2346 x 1568 pixels. Retinal fundus photograph: 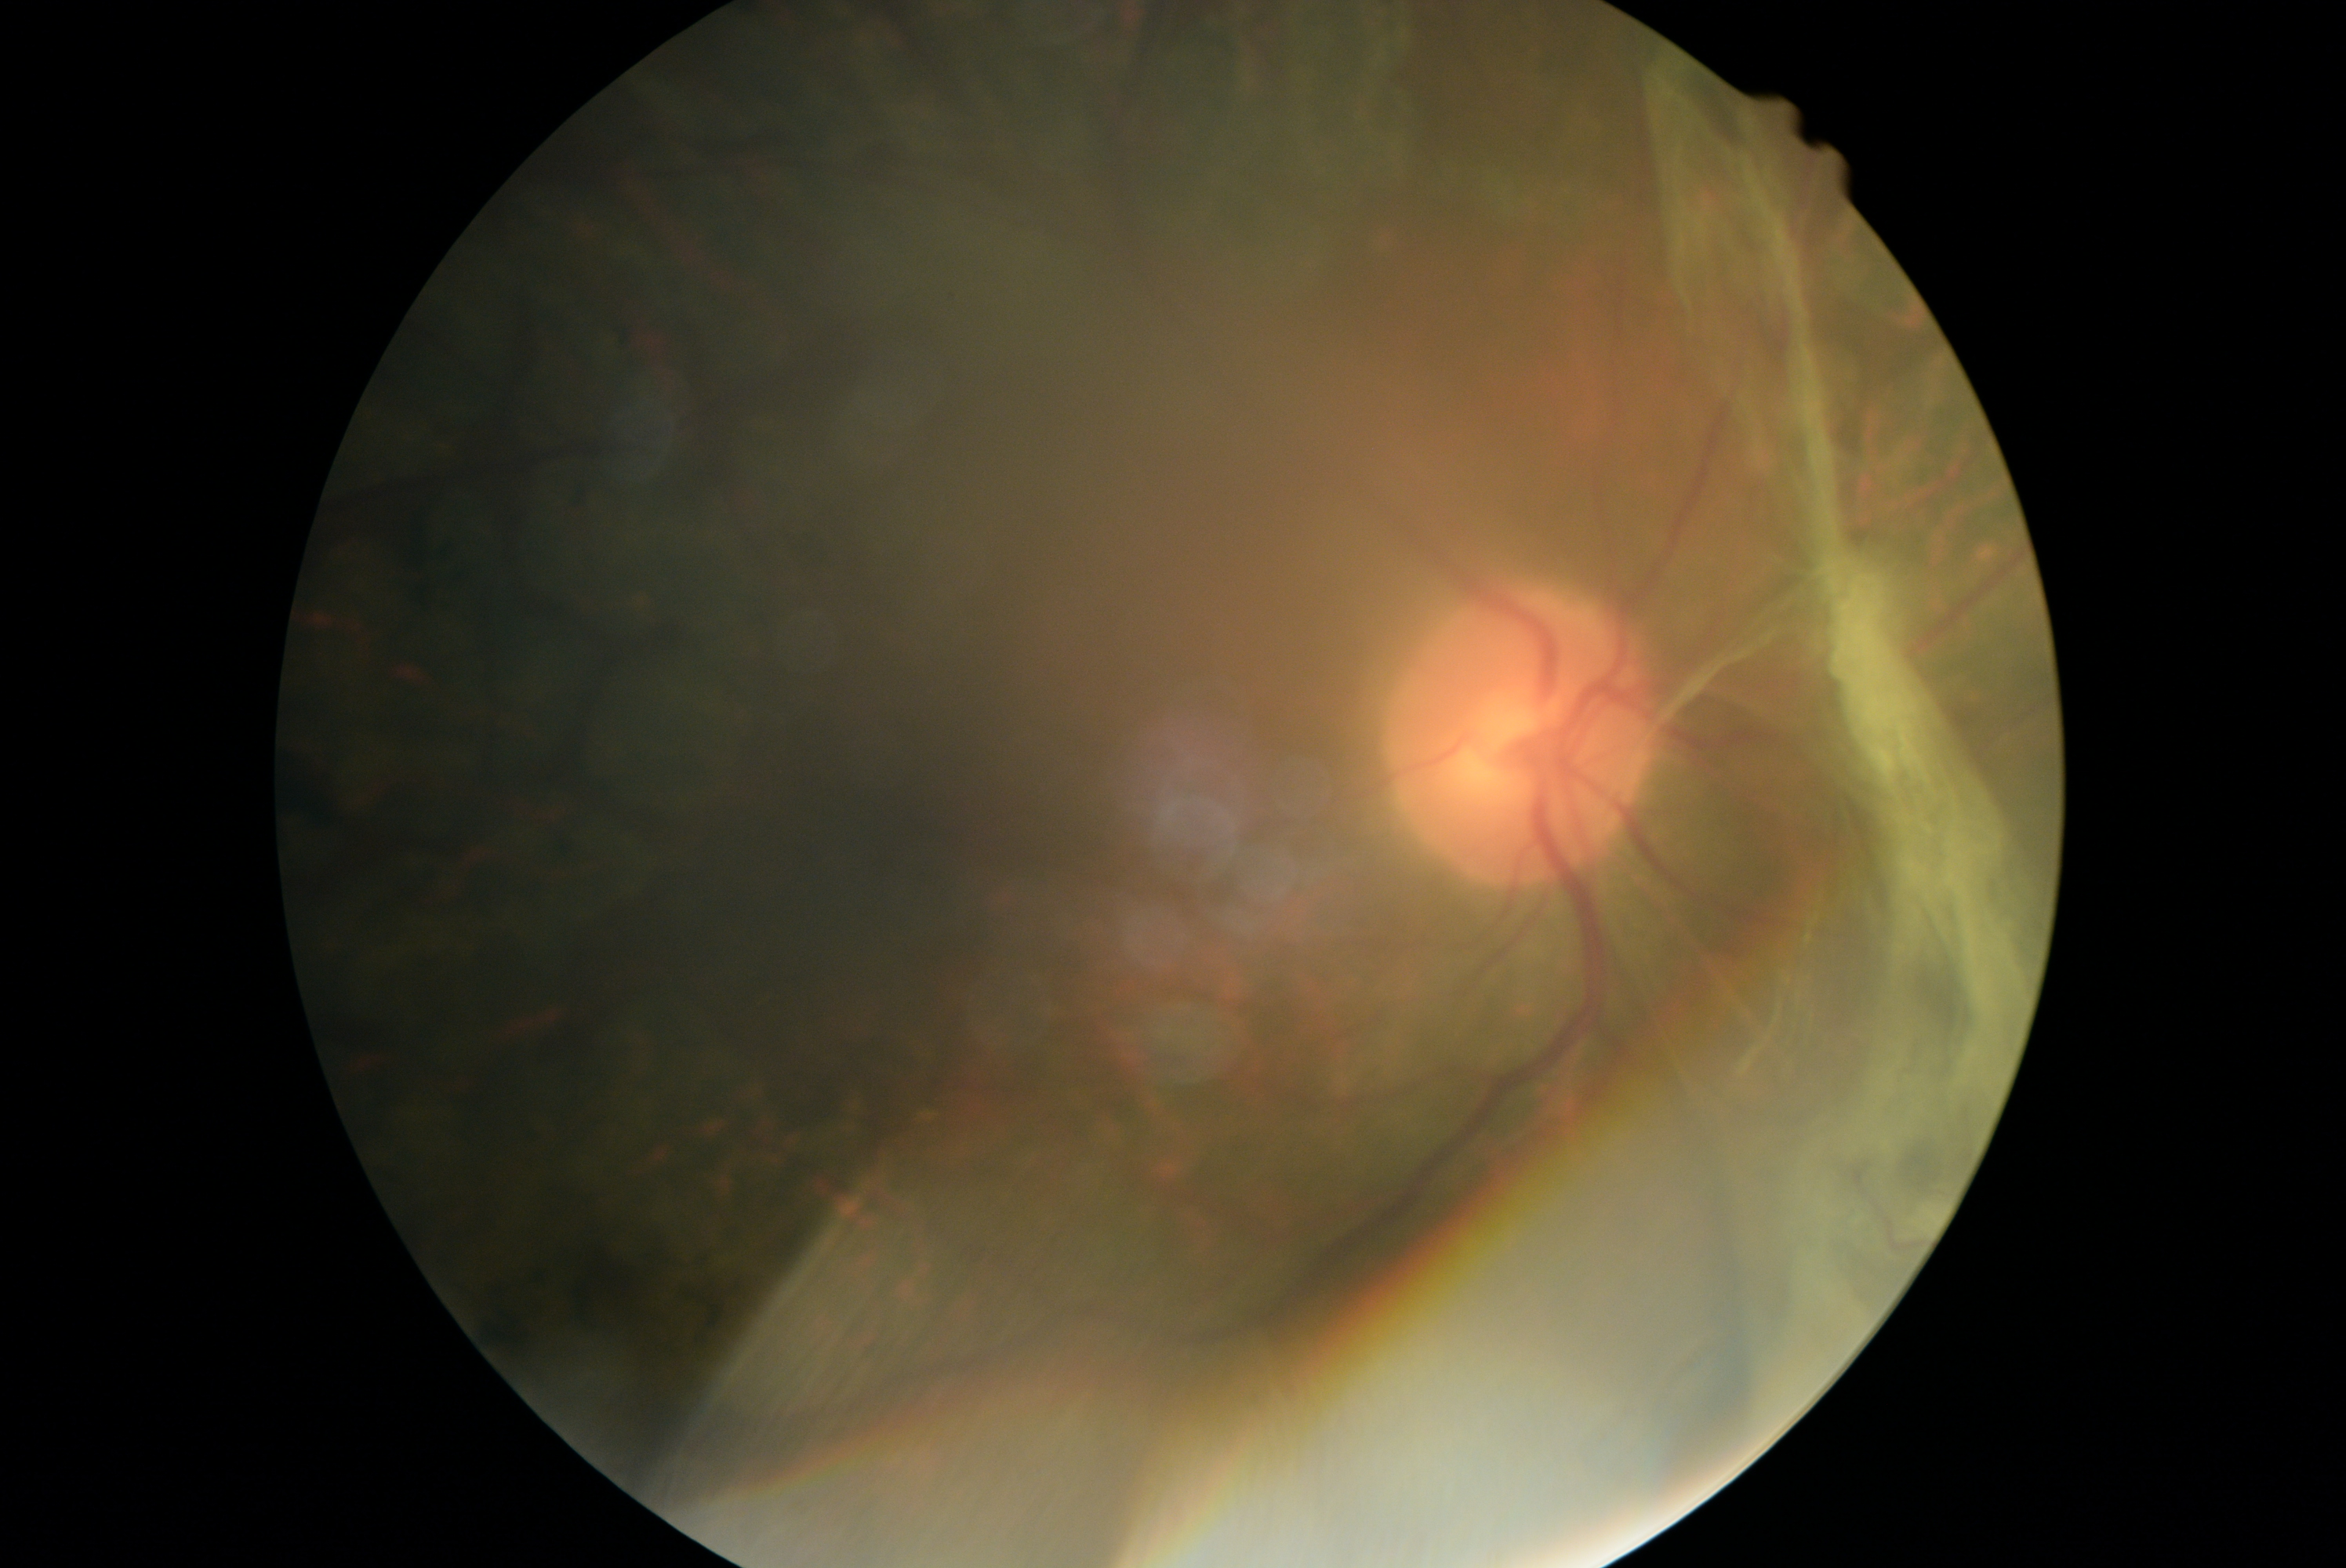

DR: 4/4.